NIDEK AFC-230, diabetic retinopathy graded by the modified Davis classification.
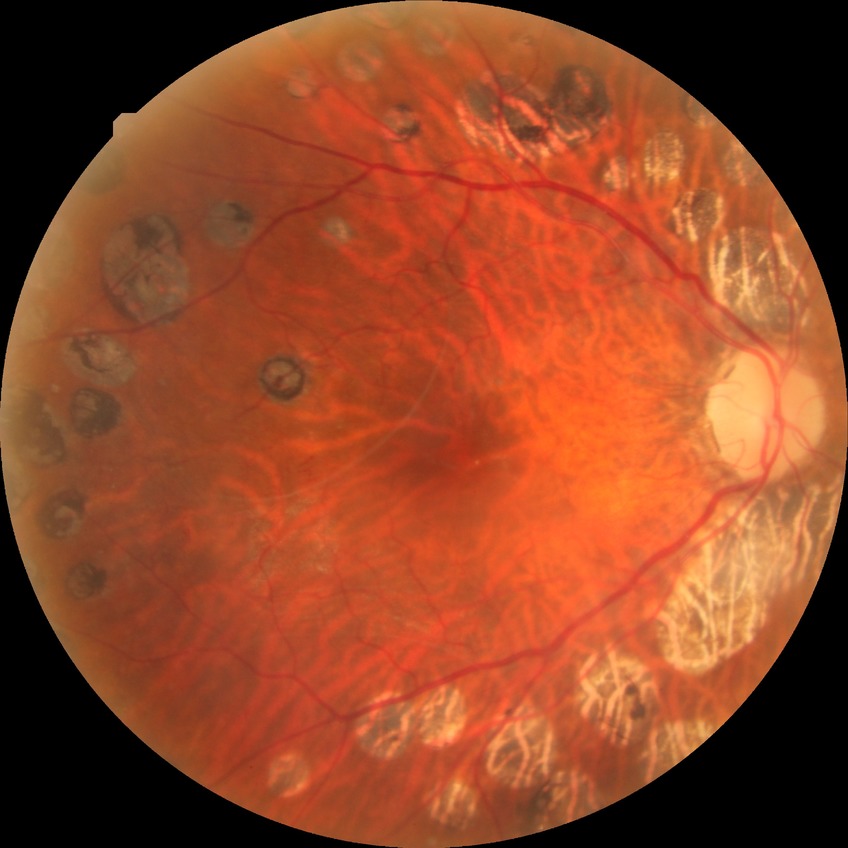
* modified Davis grade — PDR